Image size 1932x1916; color fundus photograph — 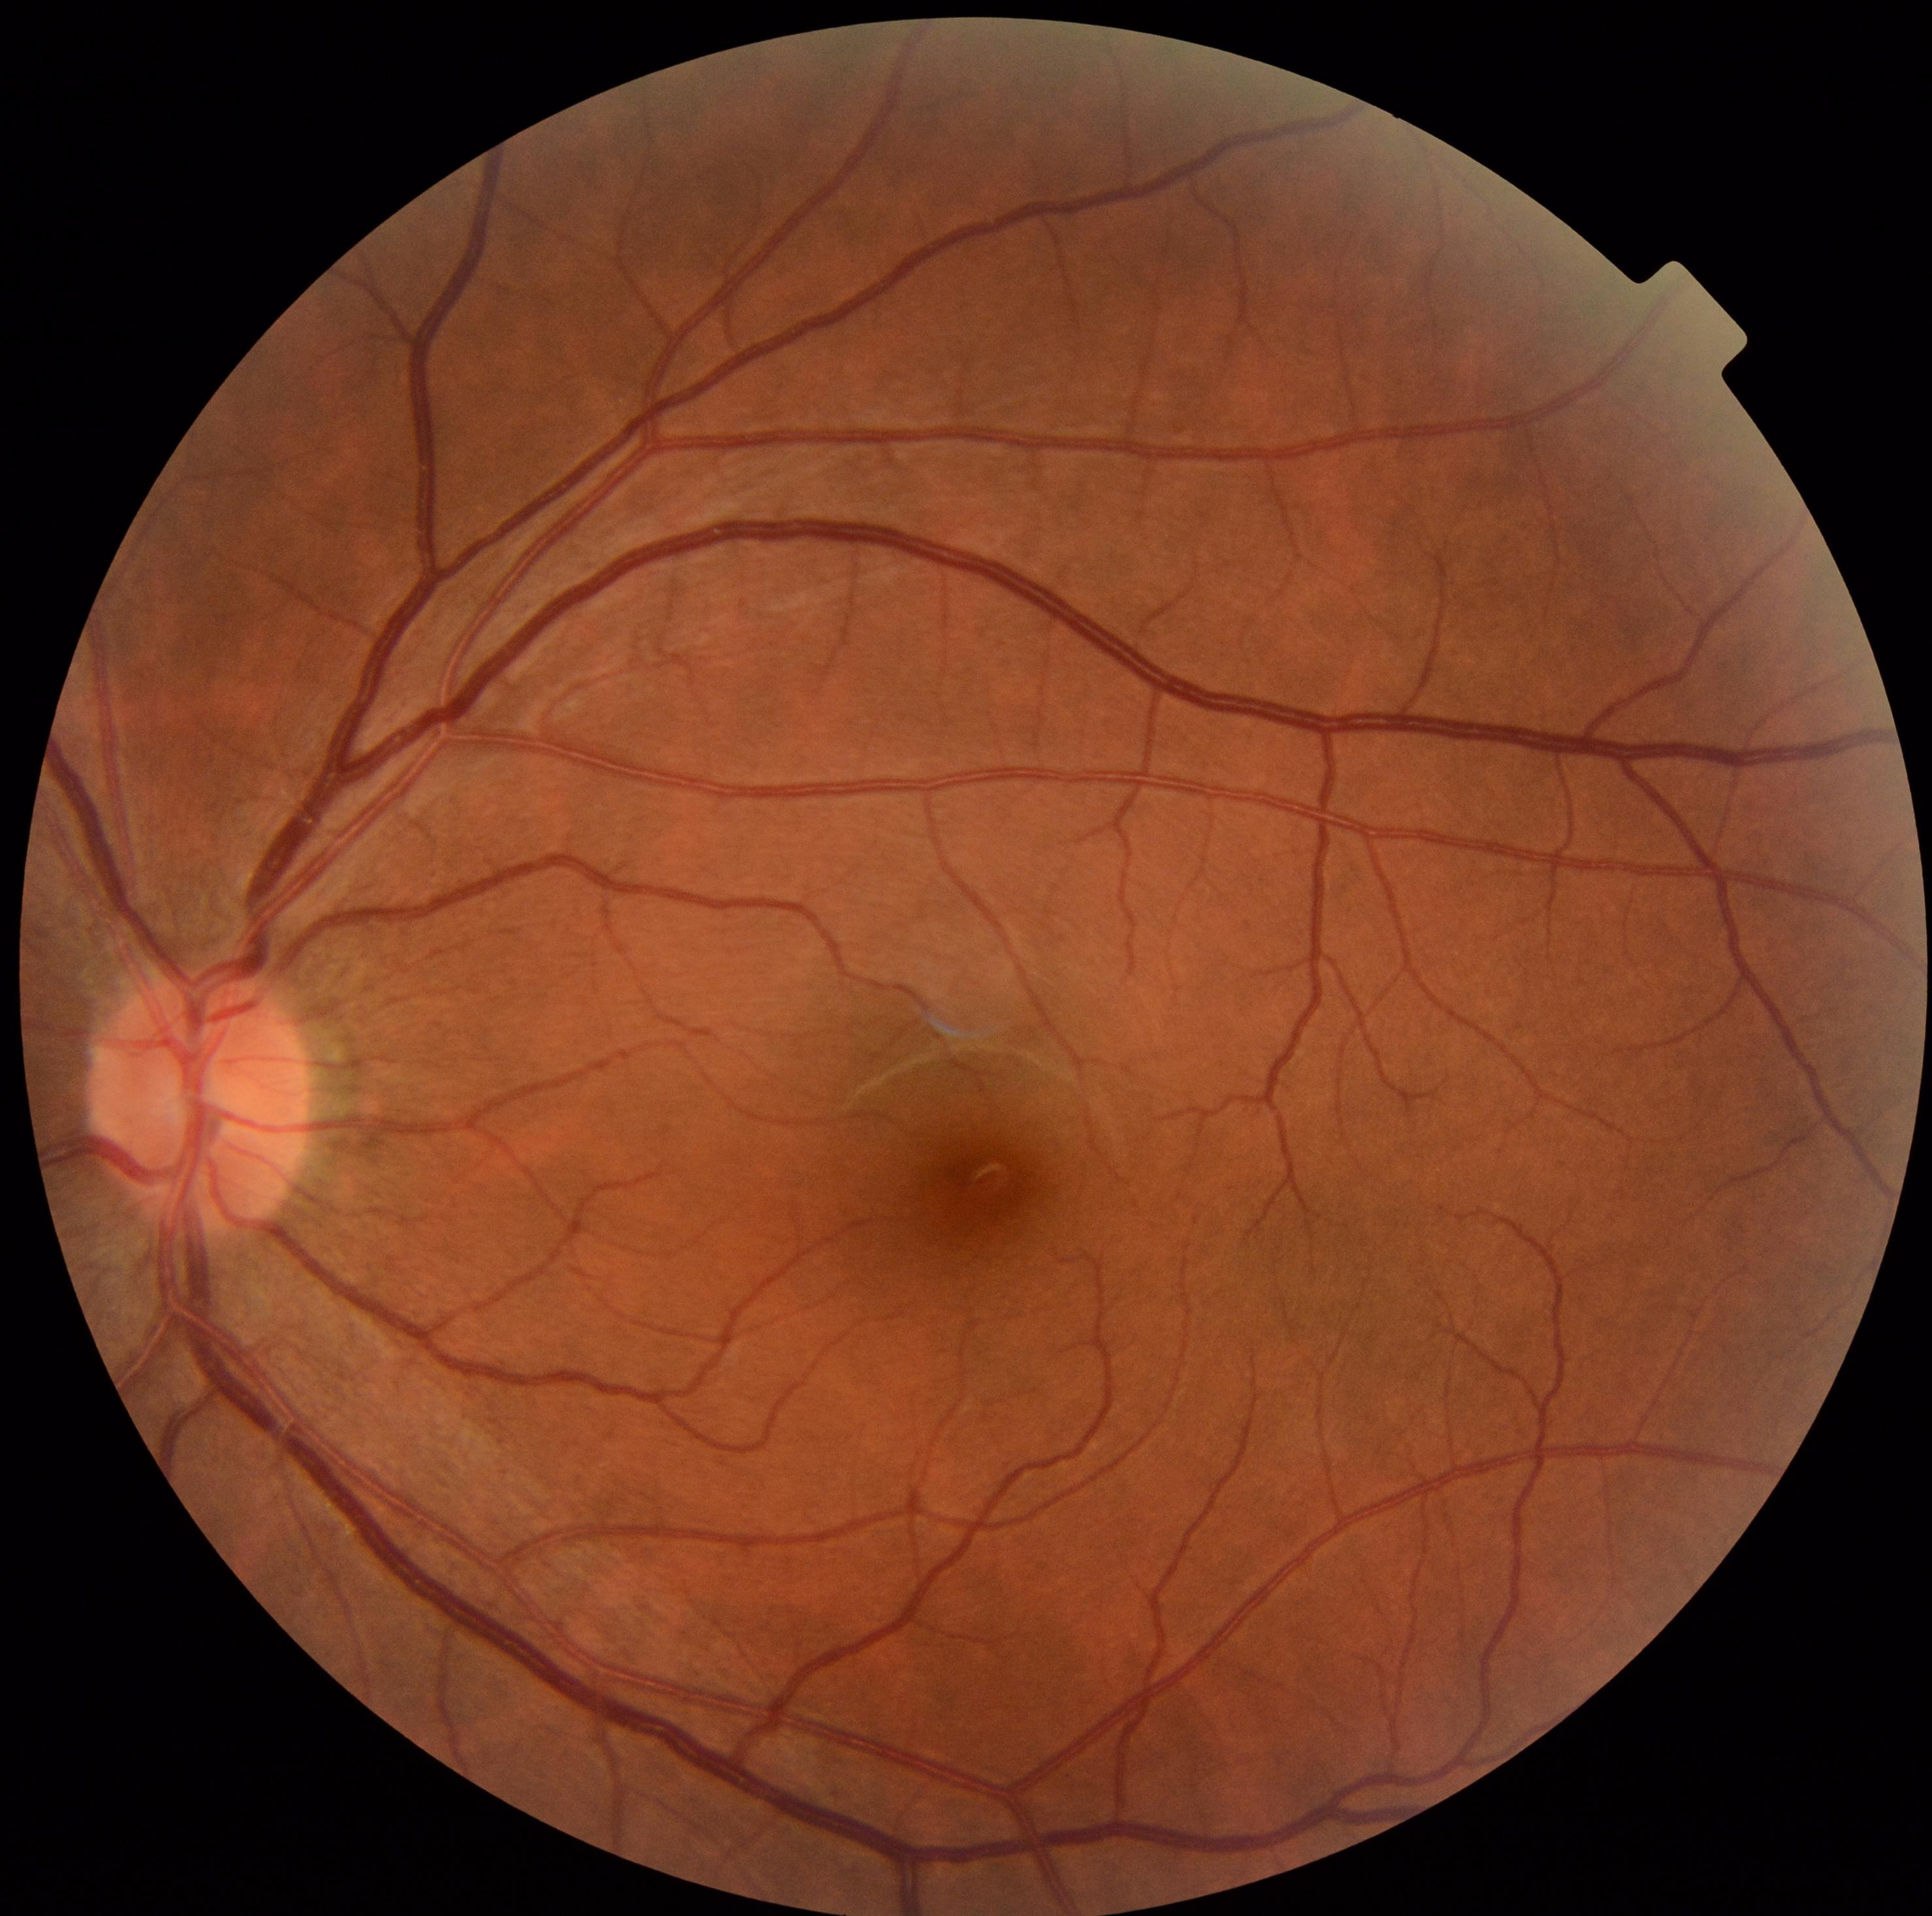
DR severity: 0 | DR impression: no signs of DR.